Retinal fundus photograph. 45-degree field of view. 848 x 848 pixels. NIDEK AFC-230:
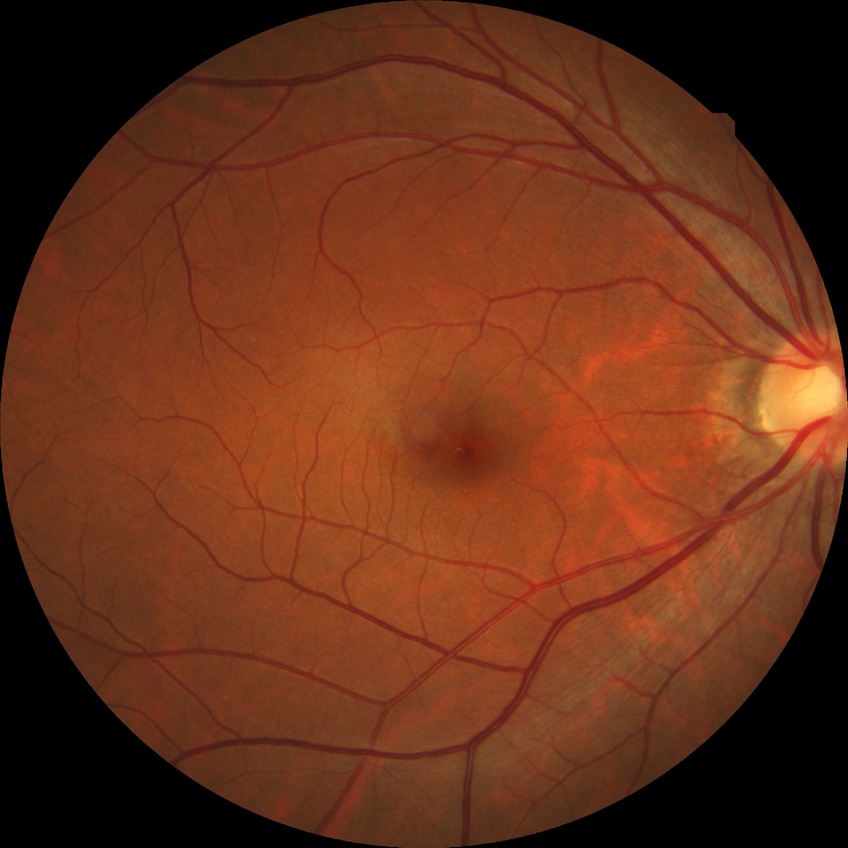

davis_grade: no diabetic retinopathy